Ultra-widefield fundus mosaic
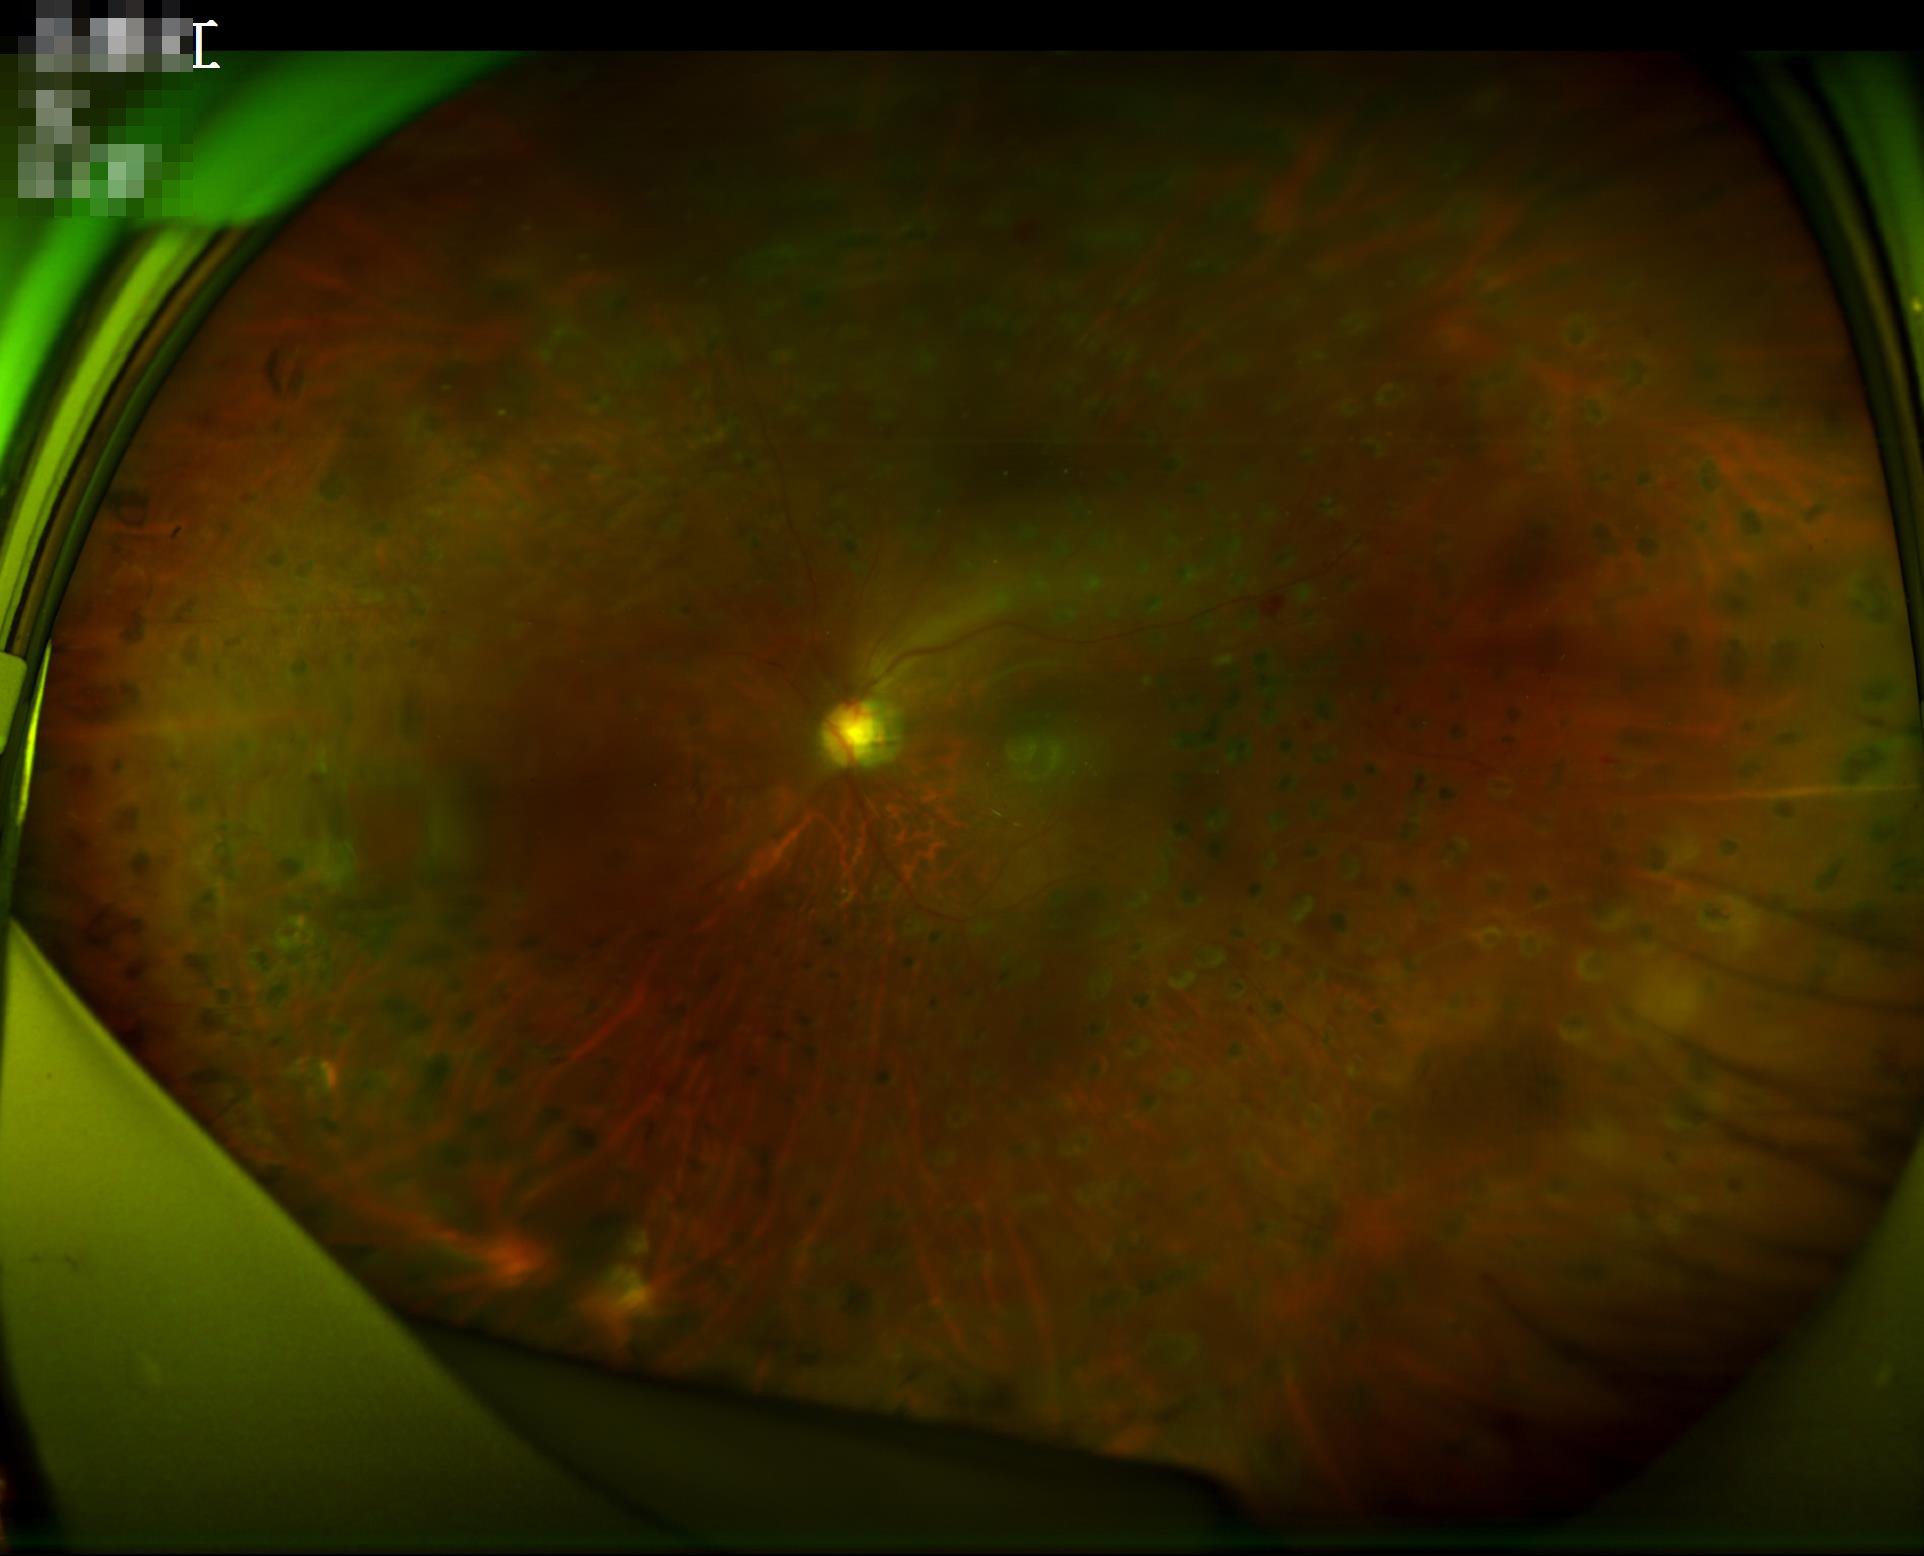 Optic disc, vessels, and background are in focus. Overall image quality is poor. Illumination and color are suboptimal. Narrow intensity range; structures are hard to distinguish.